Wide-field fundus photograph of an infant · camera: Natus RetCam Envision (130° FOV) · 1440 by 1080 pixels: 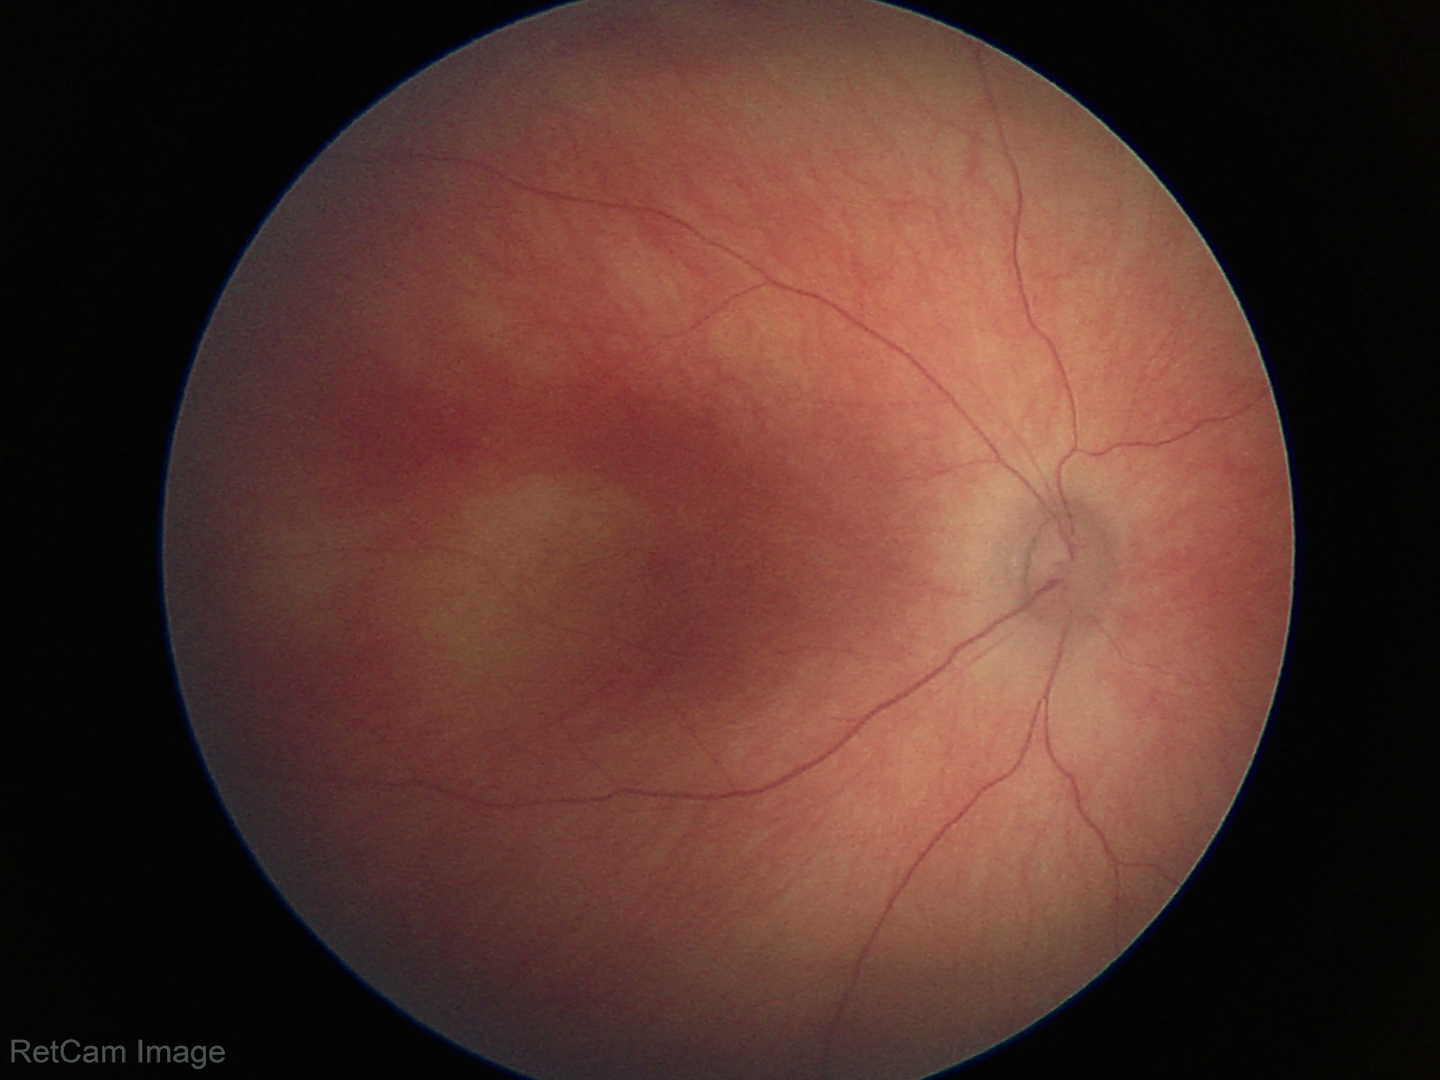
Q: What is the diagnosis from this examination?
A: no abnormal retinal findings